2352x1568px — 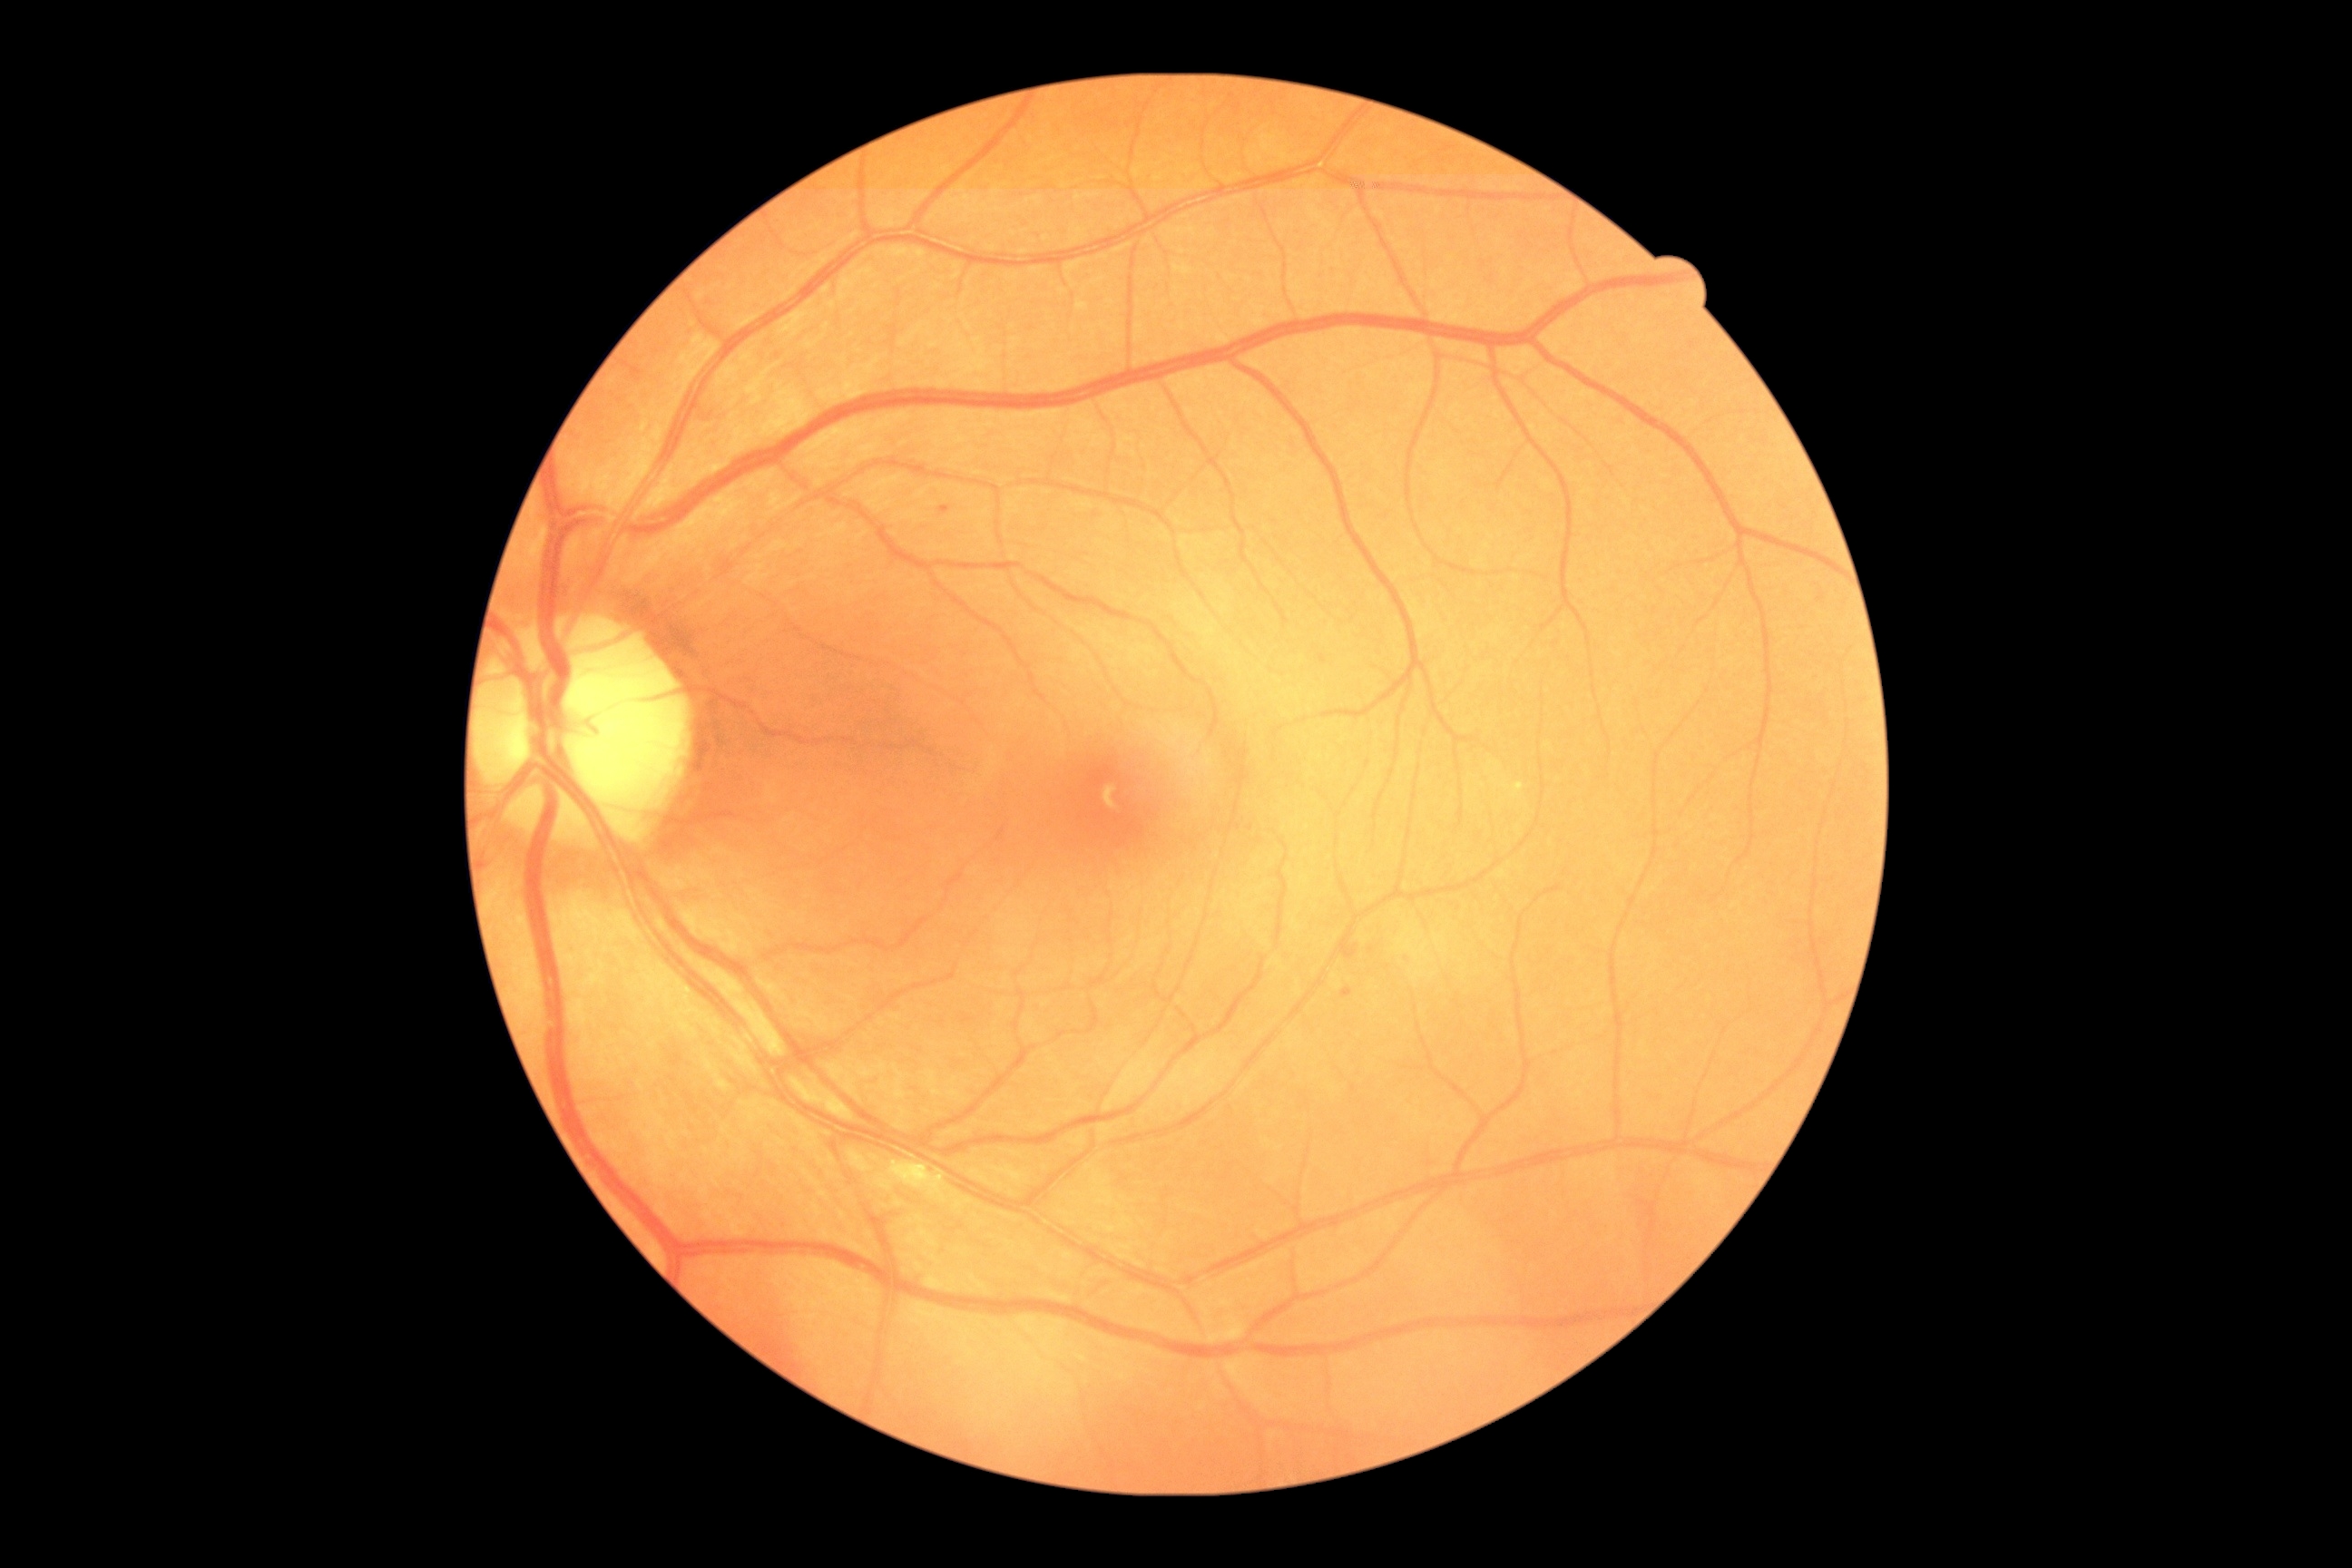
Diabetic retinopathy (DR): mild NPDR (grade 1). The retinopathy is classified as non-proliferative diabetic retinopathy.